2048x1536px.
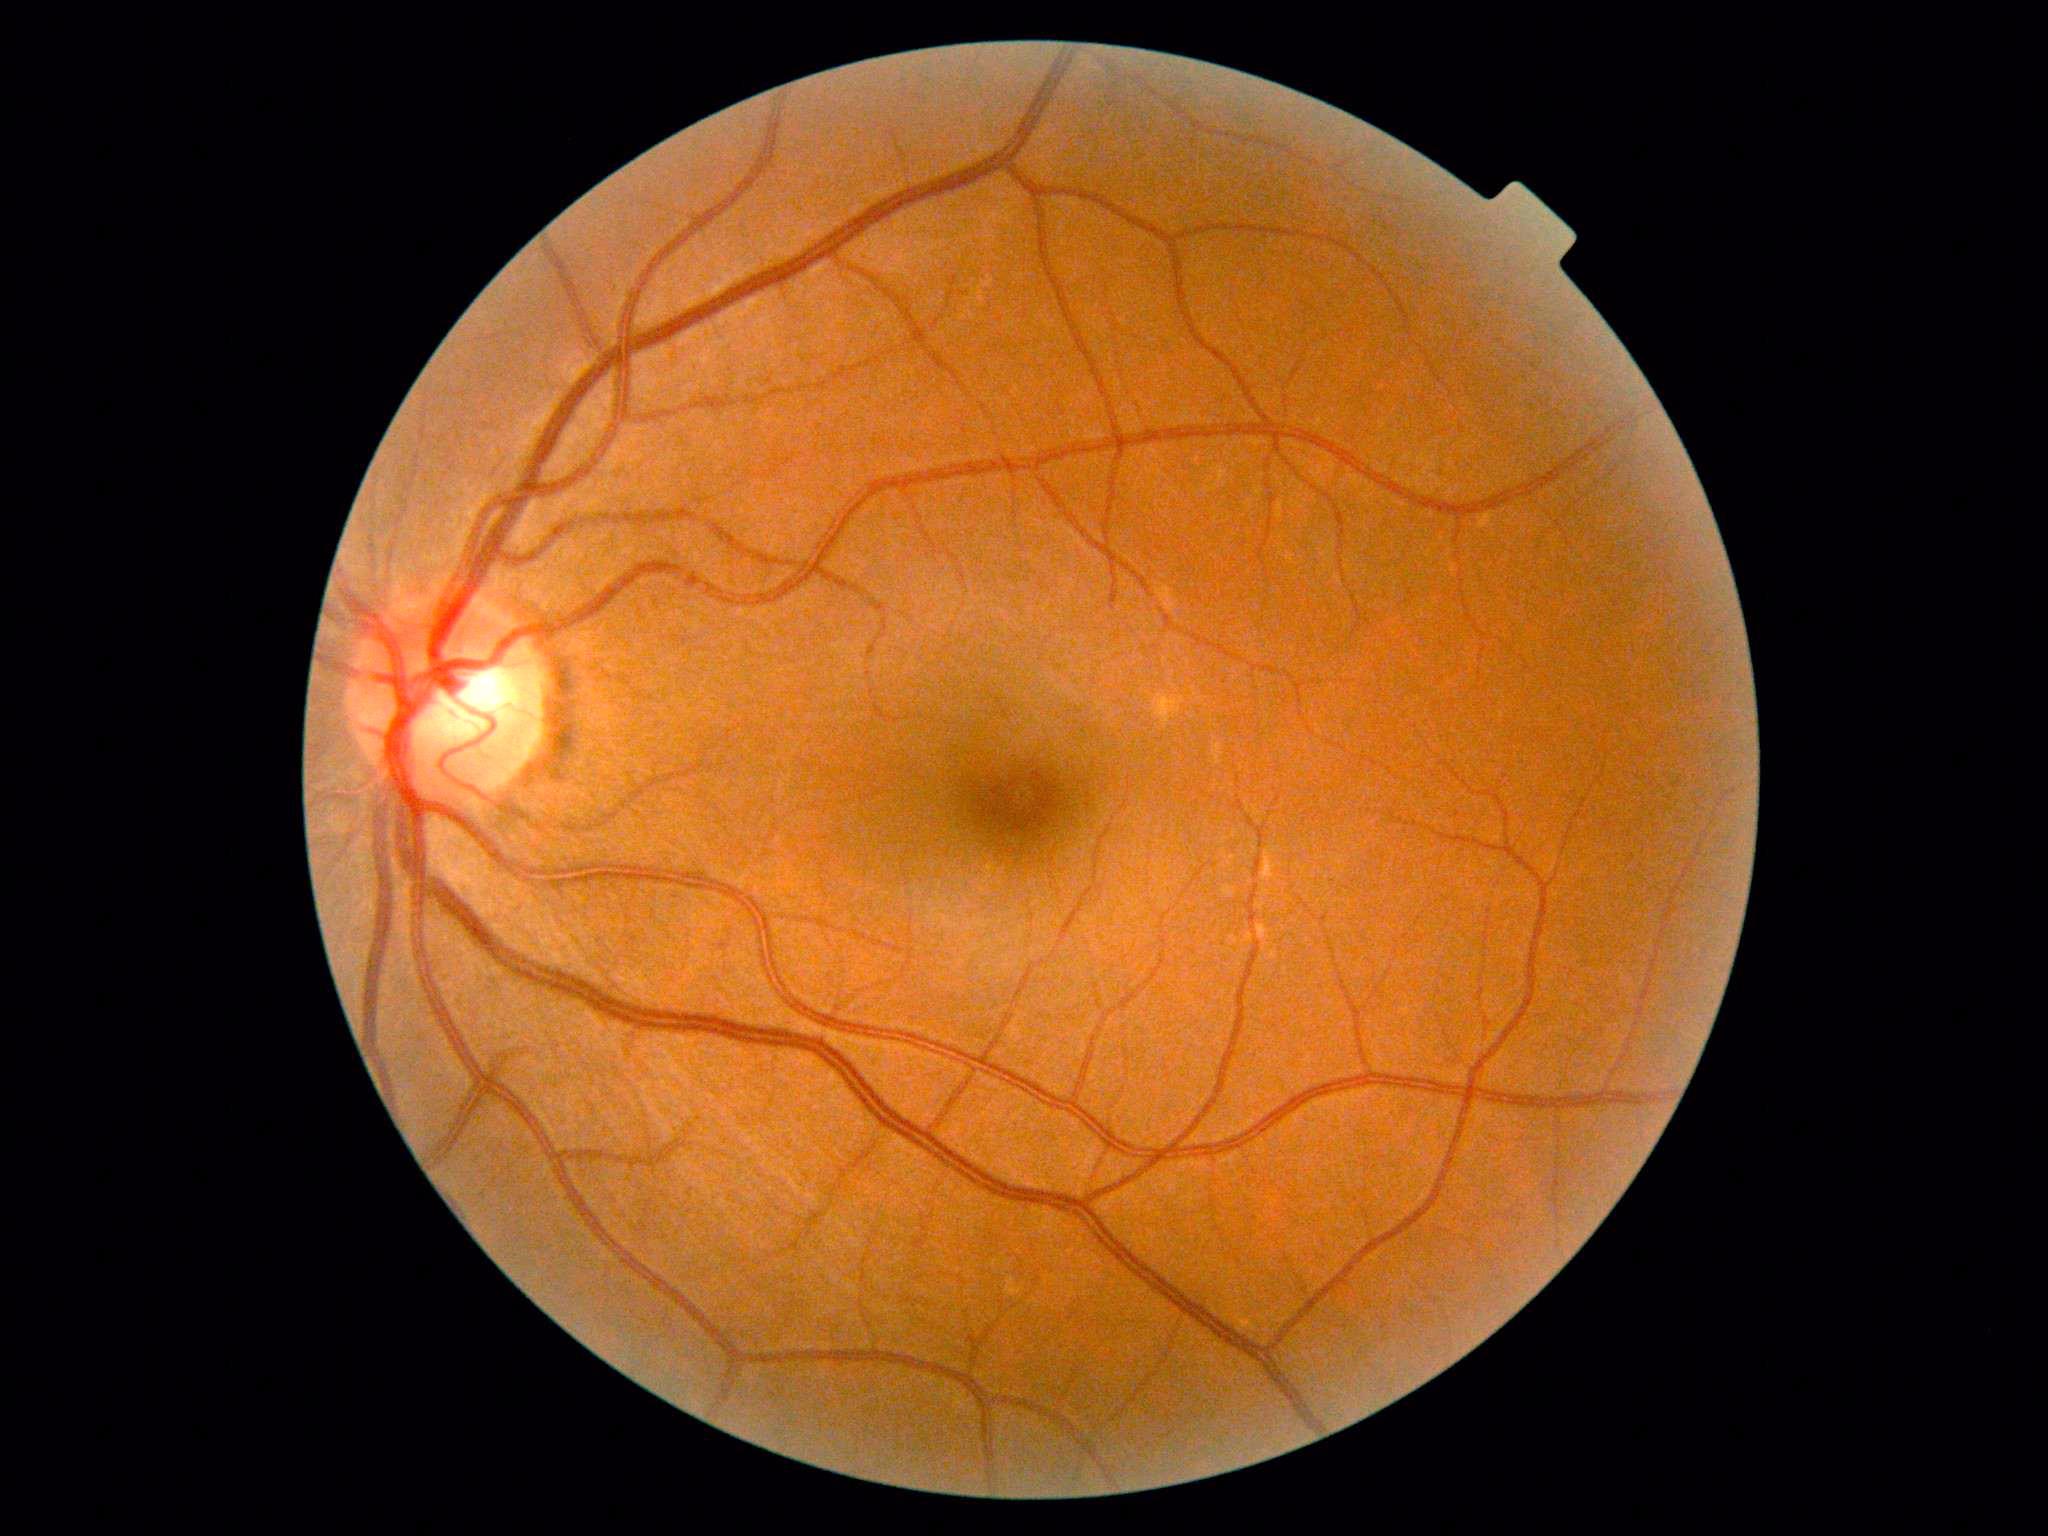

  dr_grade: grade 0 (no apparent retinopathy)